CFP · Remidio Fundus on Phone (FOP) camera — 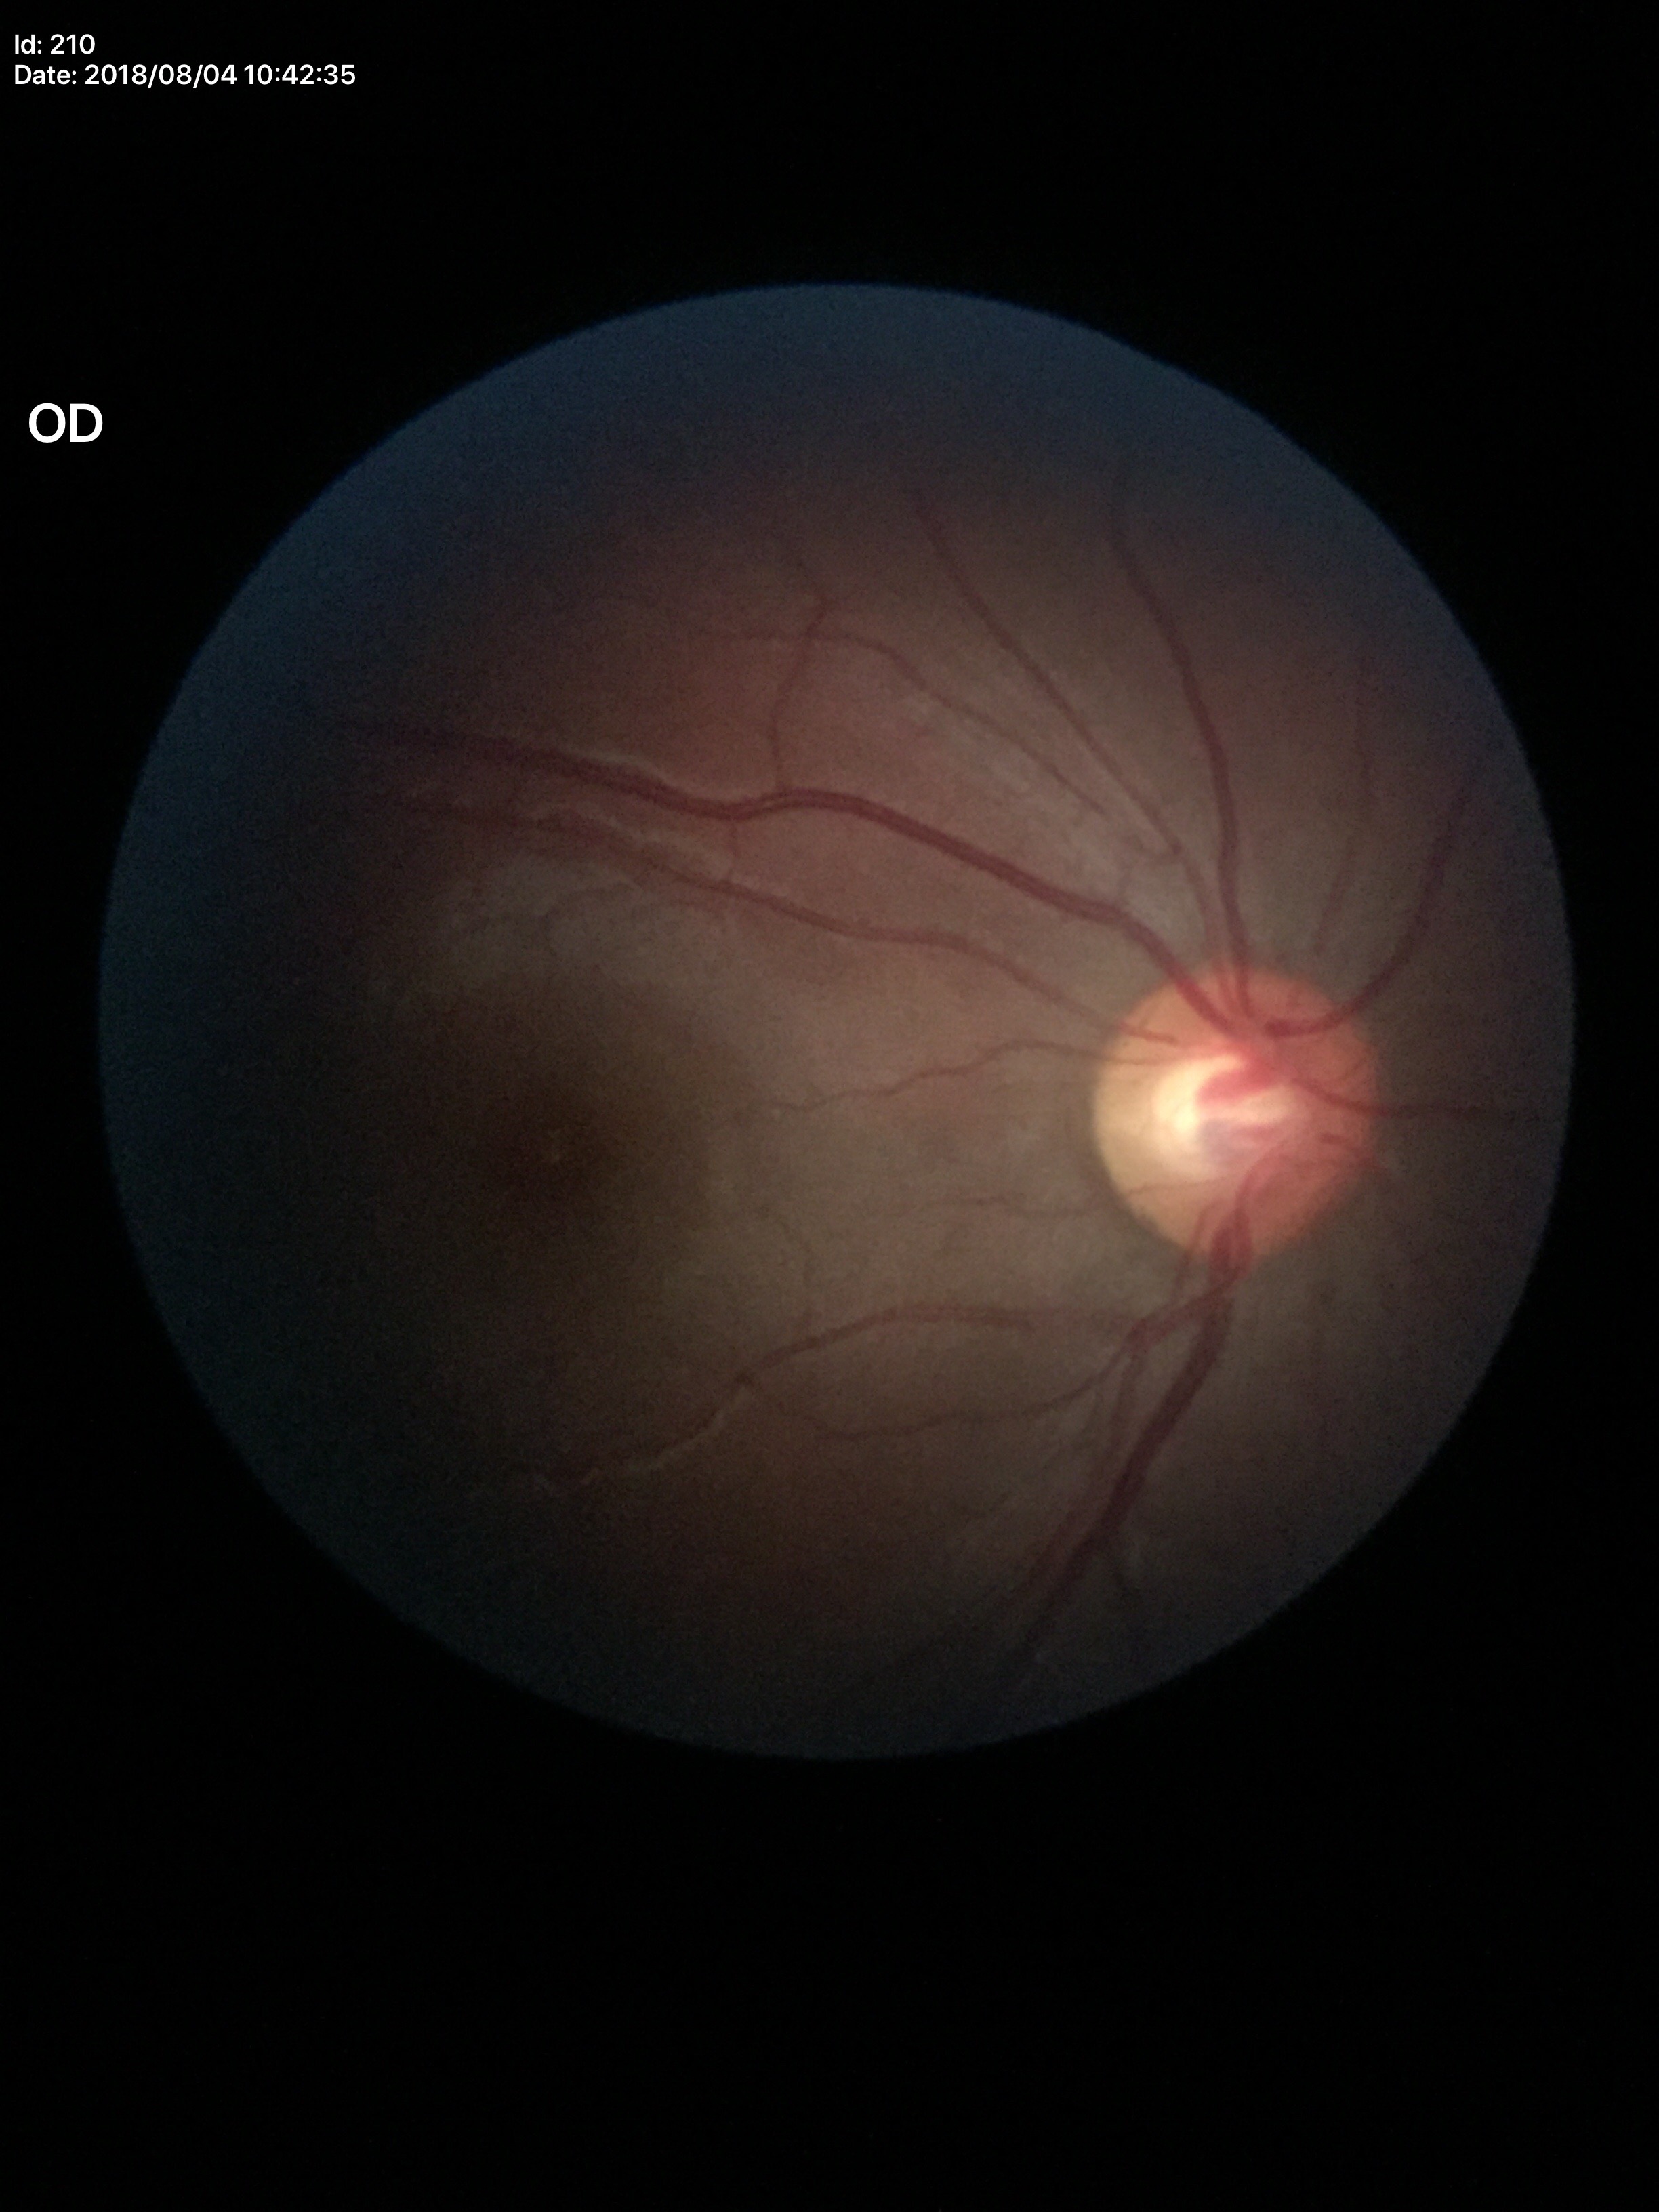
Q: Is there glaucoma suspicion?
A: not suspect (1 of 5 graders flagged glaucoma suspect)
Q: What is the VCDR?
A: 0.56